Image size 2352x1568, CFP, 45° field of view:
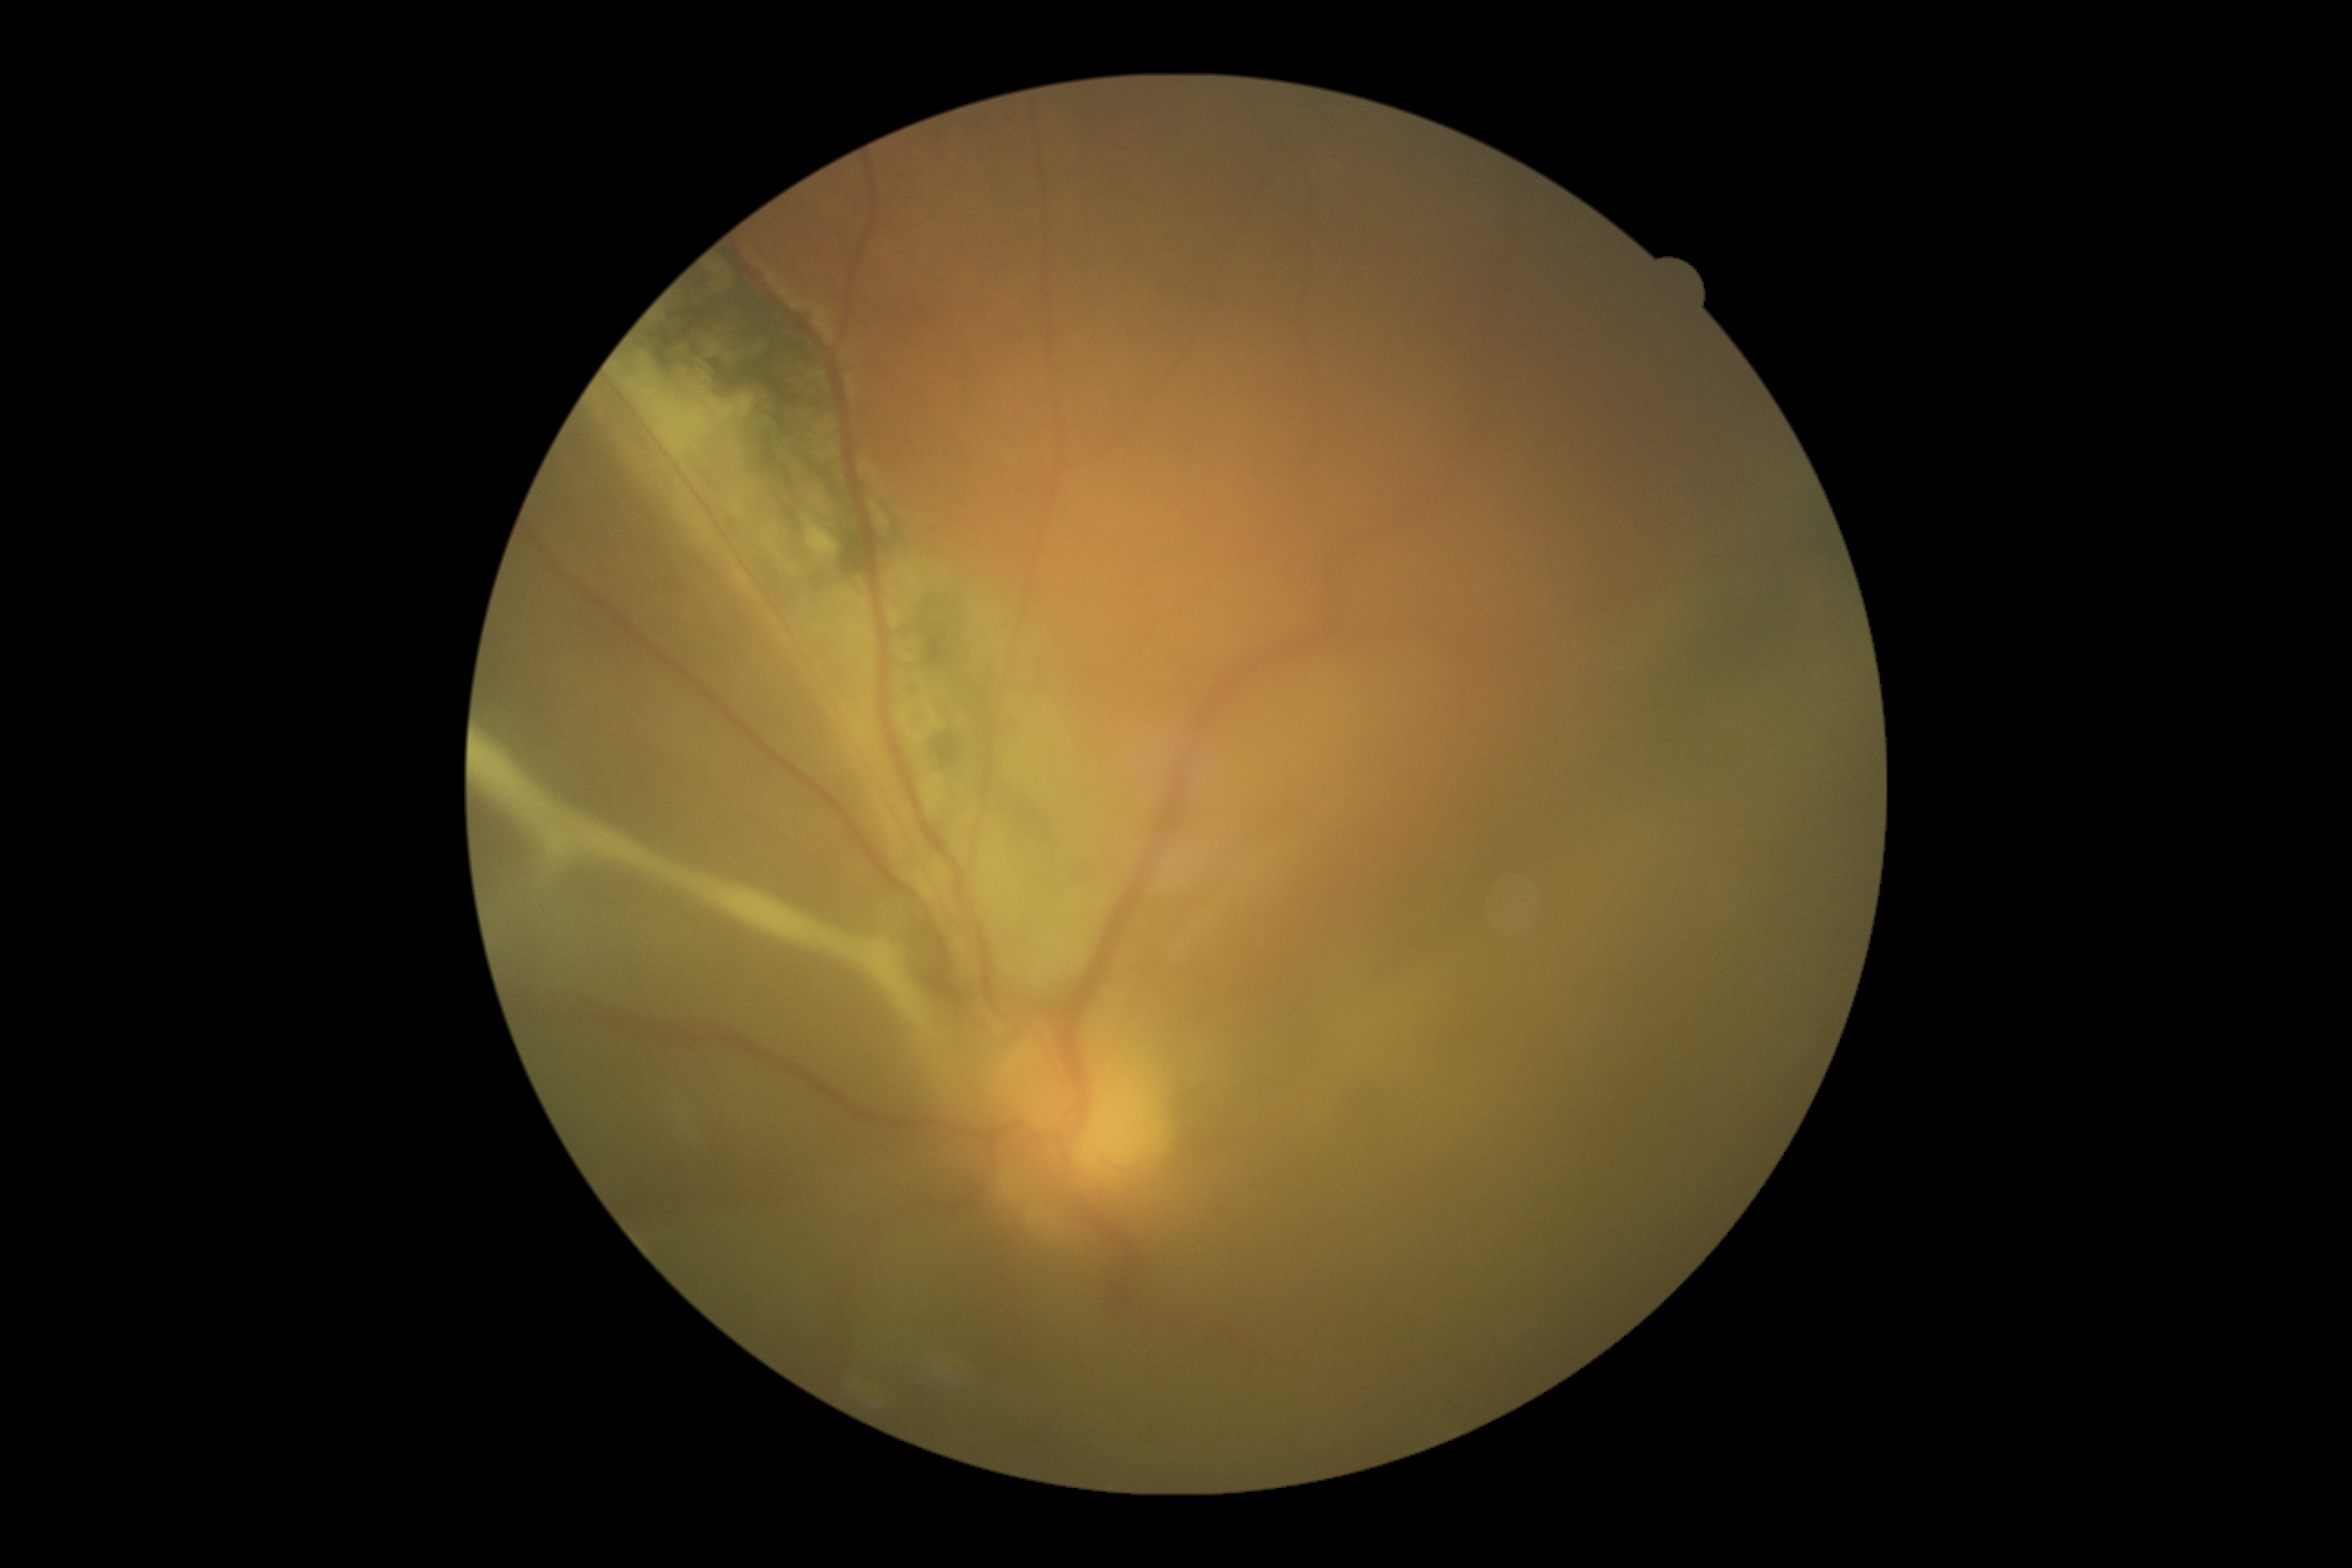
Diabetic retinopathy (DR): 4/4. Disease class: proliferative diabetic retinopathy.